Wide-field fundus photograph of an infant; acquired on the Clarity RetCam 3 — 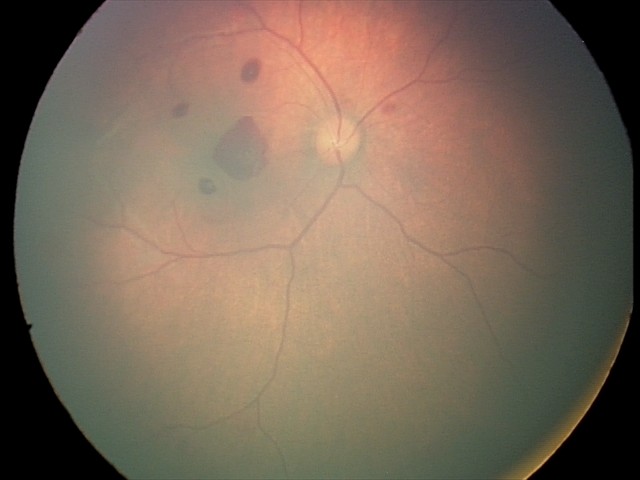 Q: What is the screening diagnosis?
A: retinal hemorrhages